Modified Davis grading — 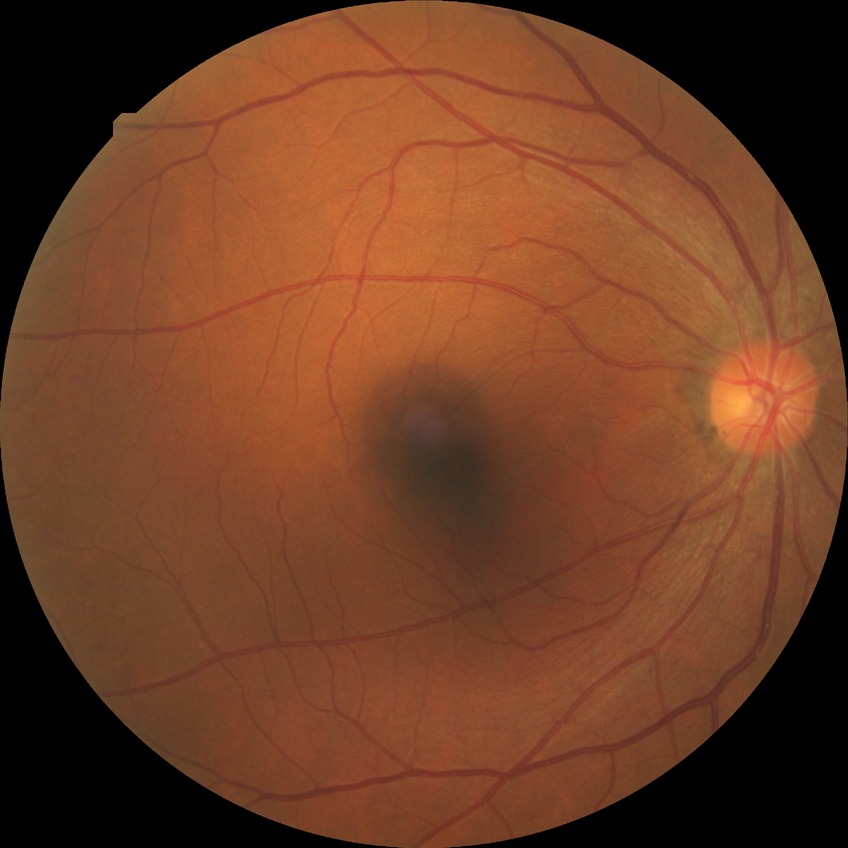
Annotations:
– diabetic retinopathy (DR) — simple diabetic retinopathy (SDR)